Color fundus photograph: 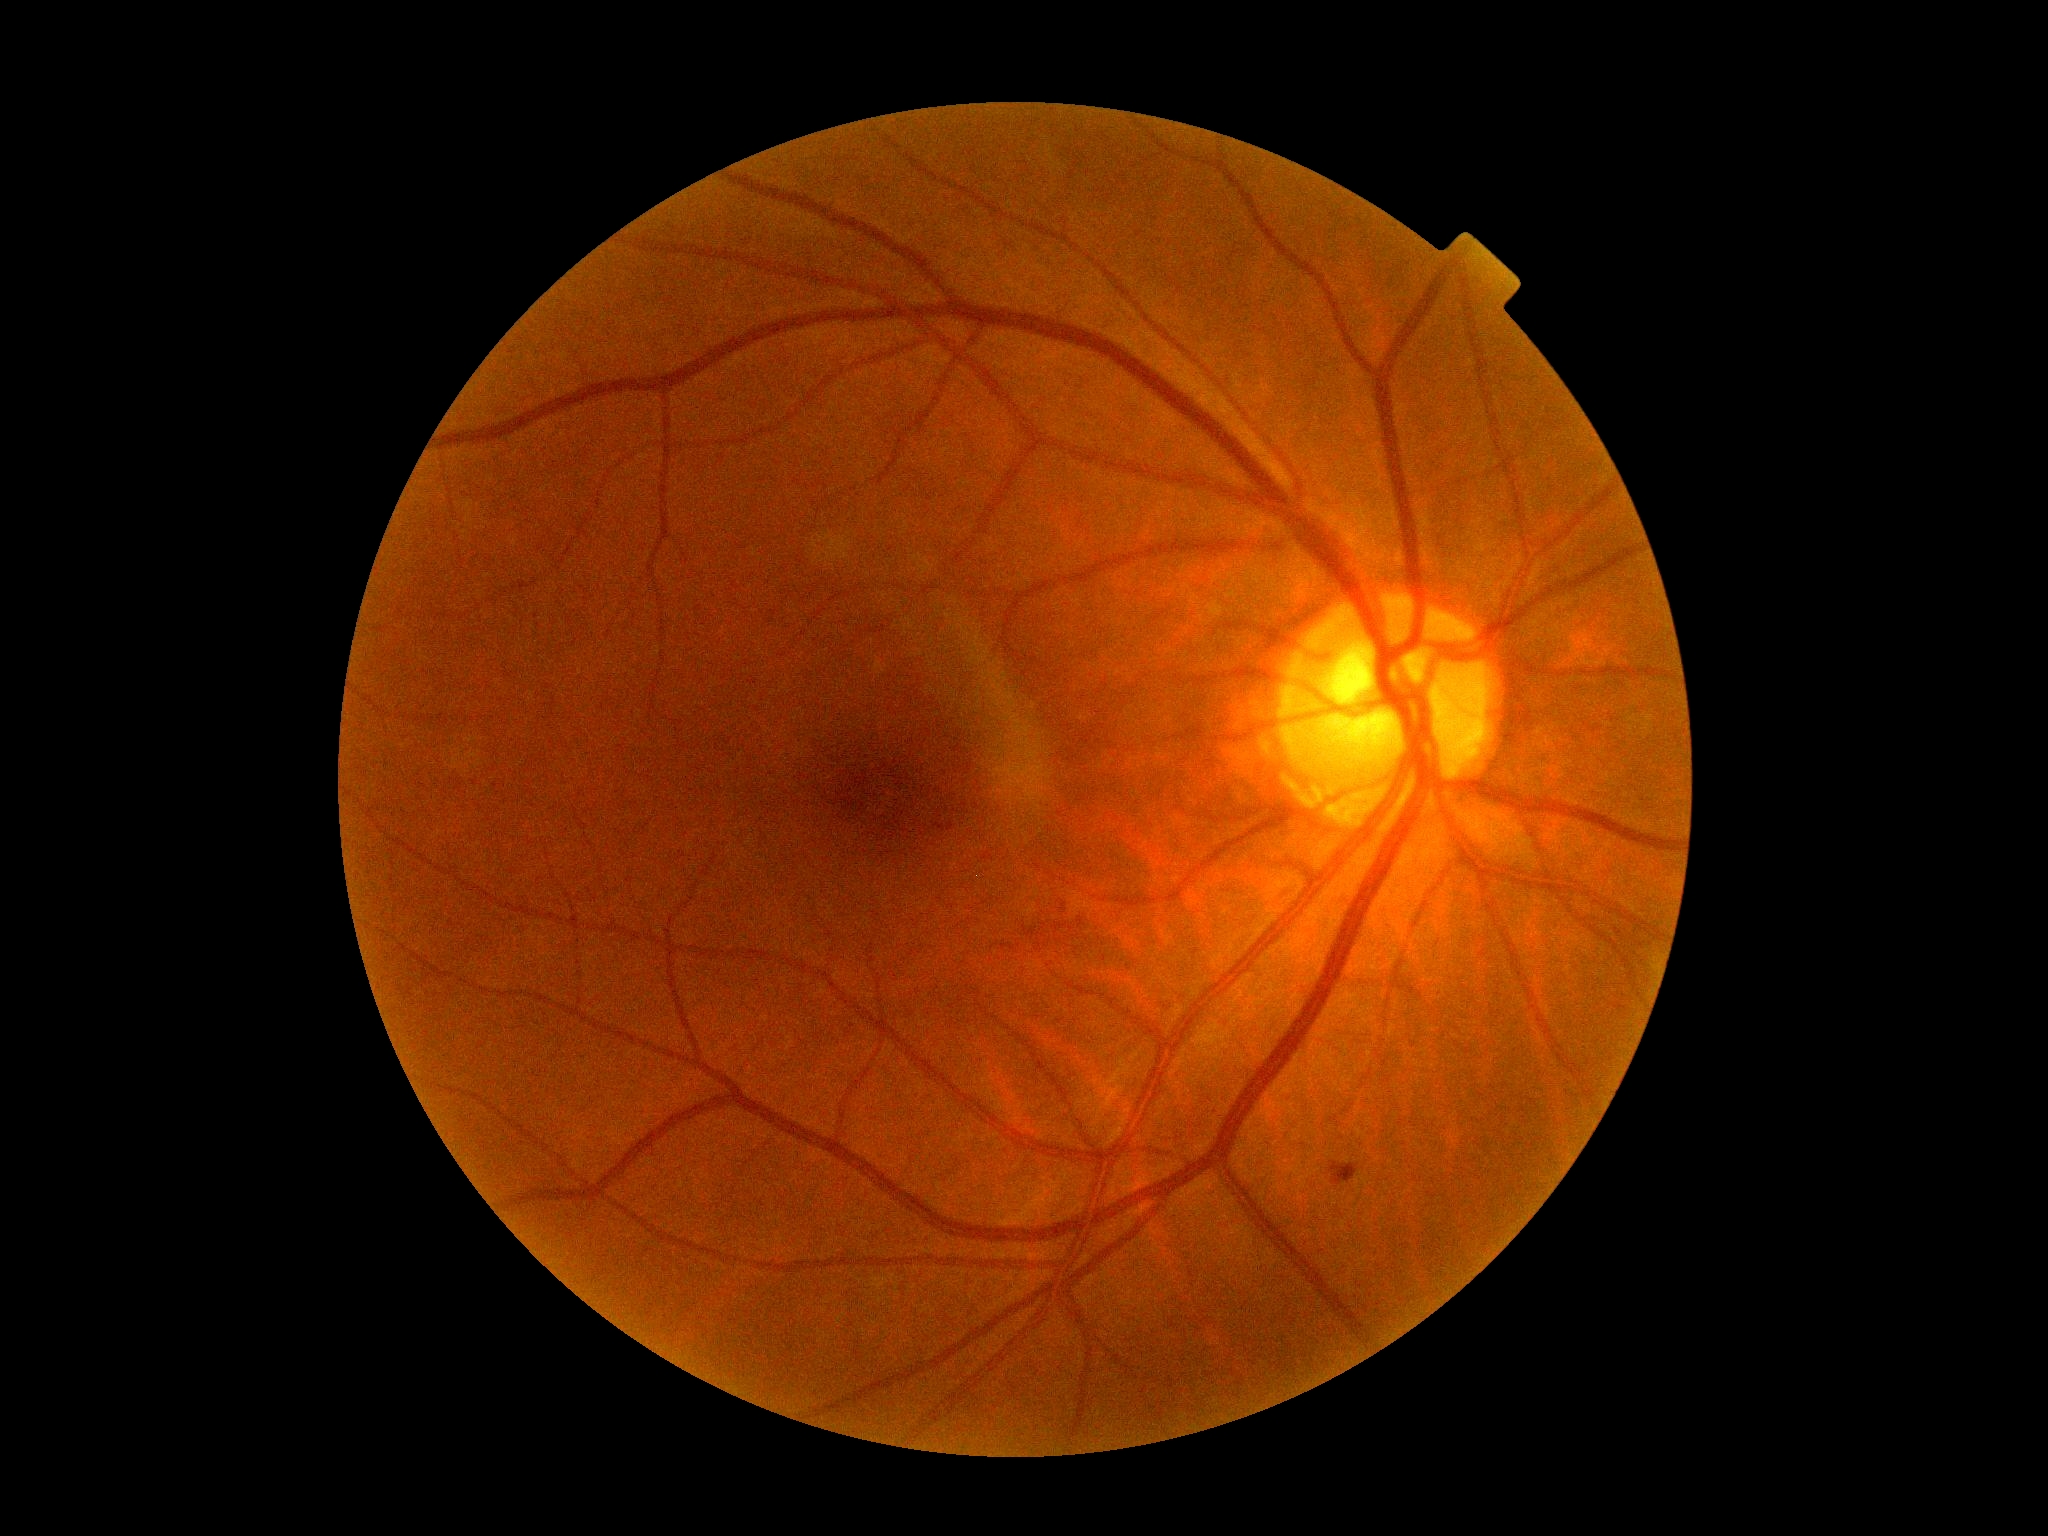

{
  "dr_category": "non-proliferative diabetic retinopathy",
  "dr_grade": "2"
}